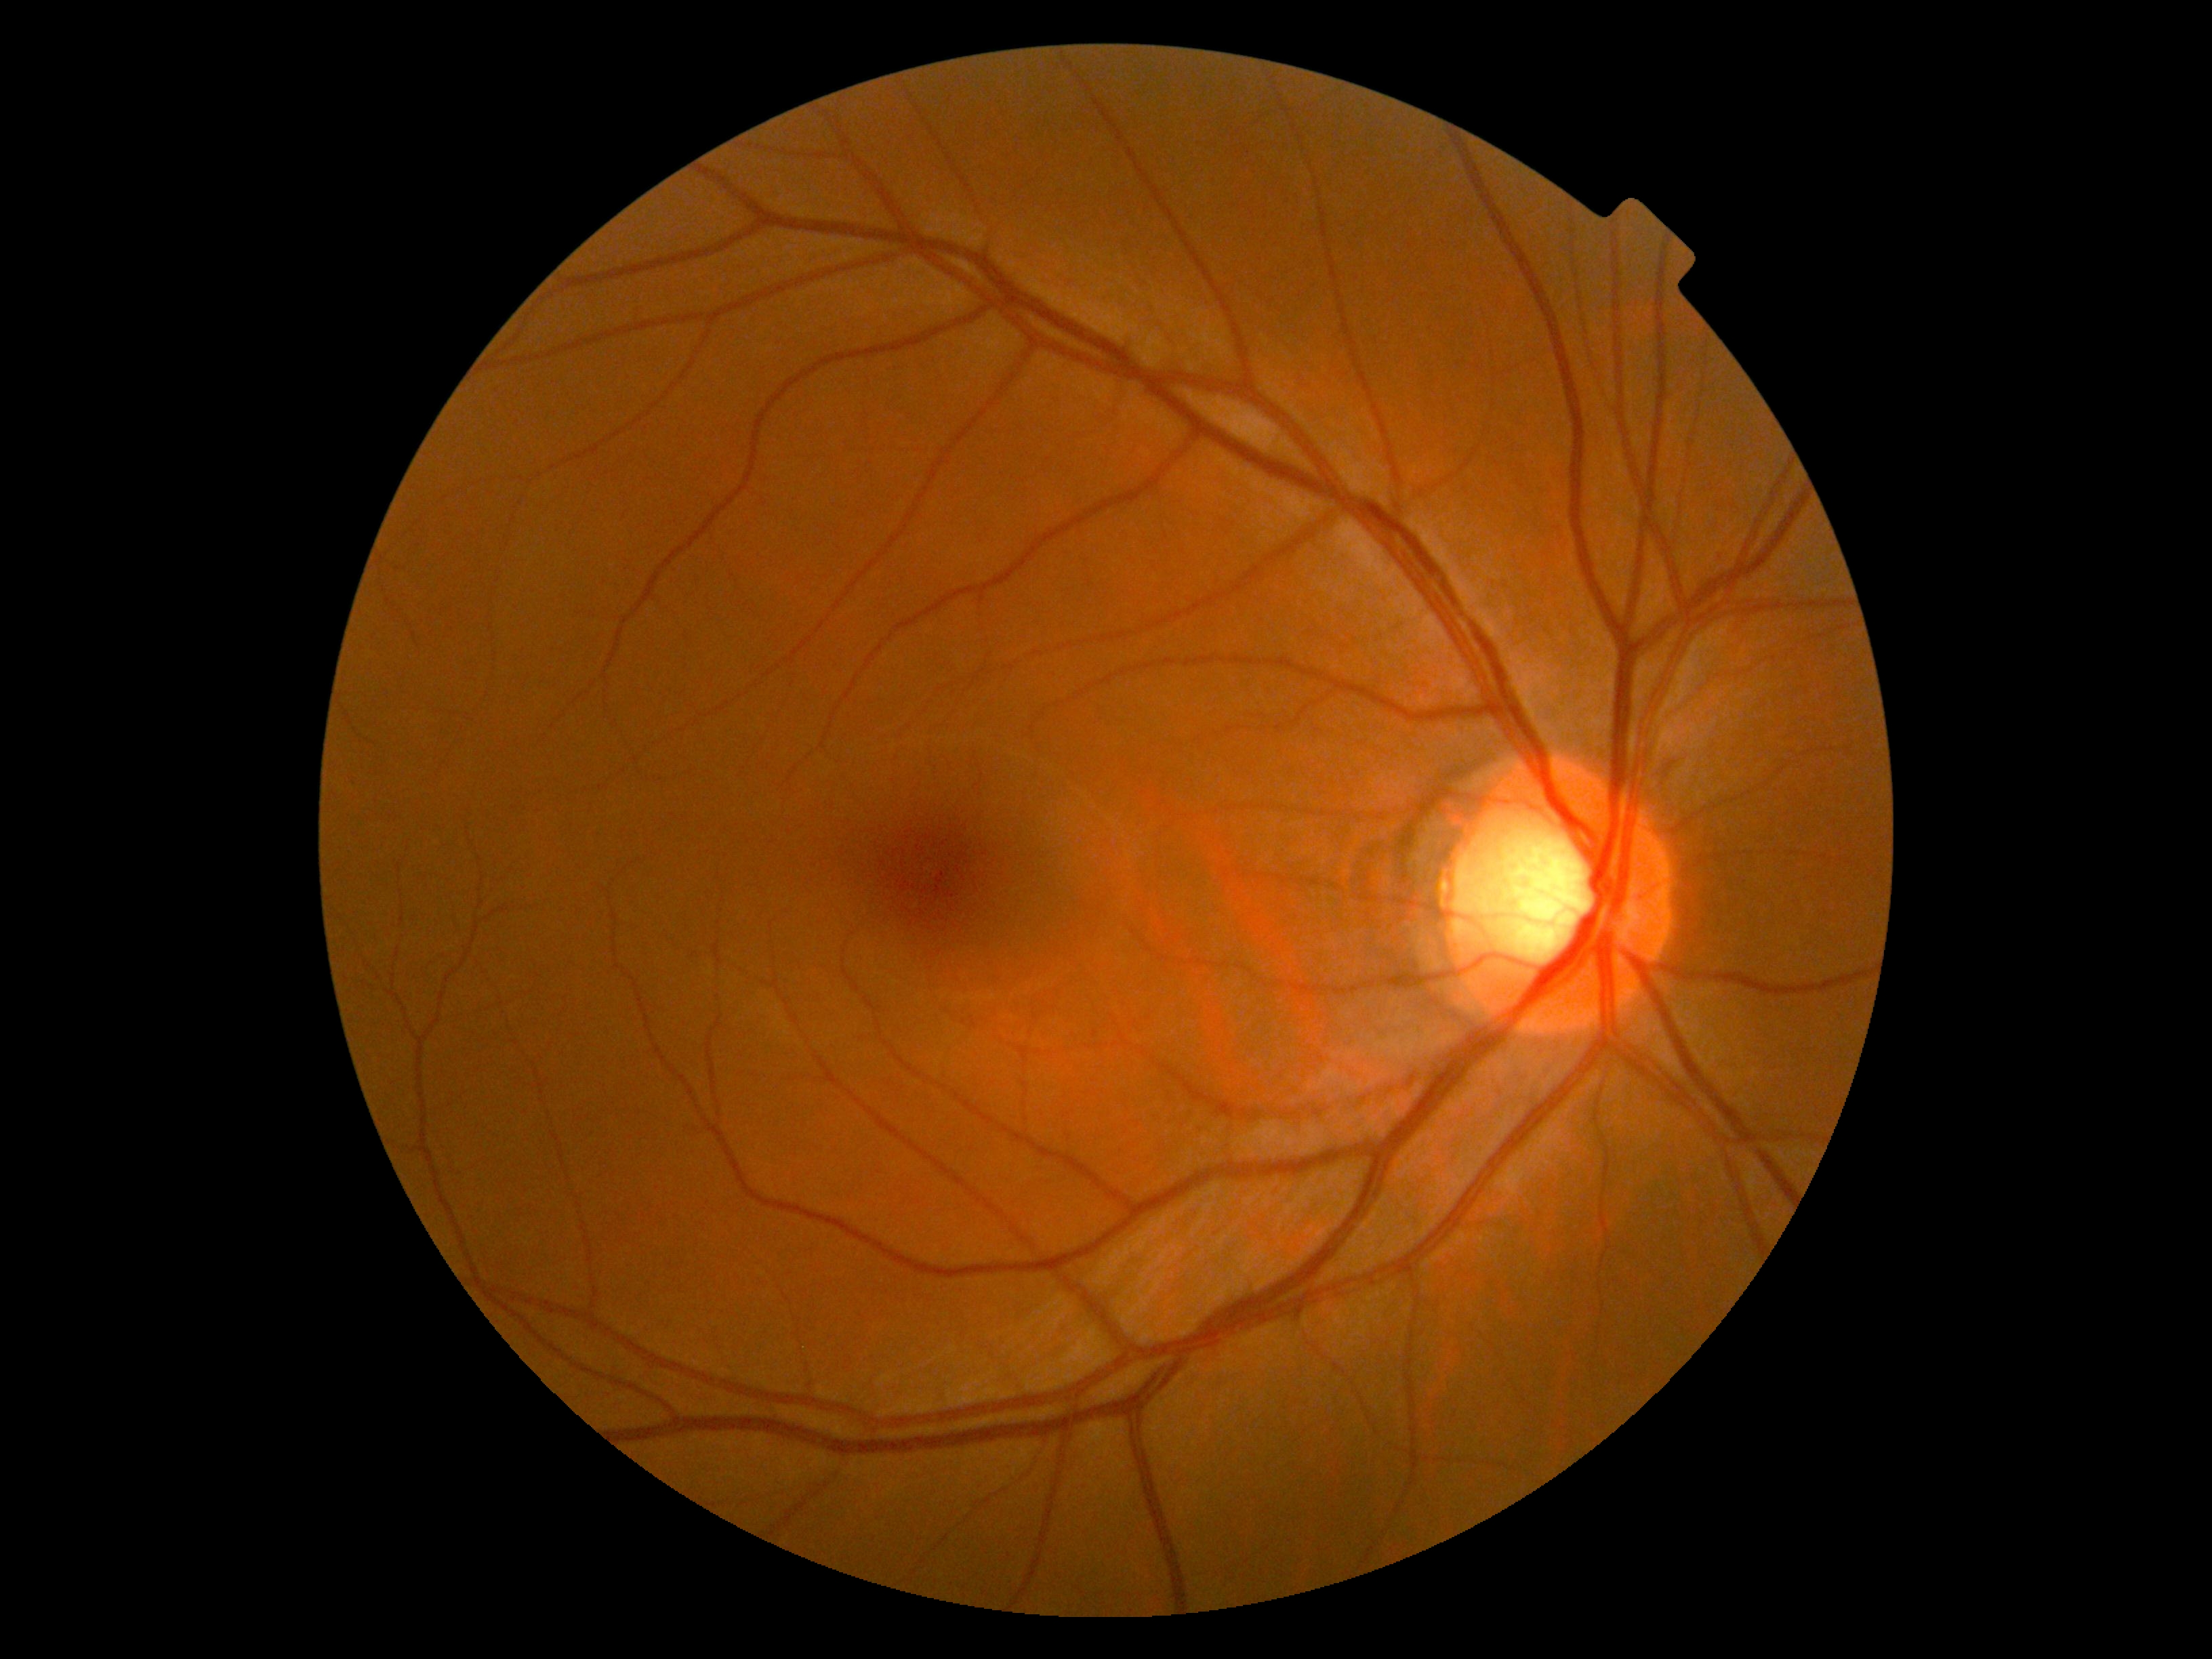 DR impression: no signs of DR | diabetic retinopathy (DR): 0/4 — no visible signs of diabetic retinopathy.